45 degree fundus photograph. NIDEK AFC-230 fundus camera. Posterior pole photograph.
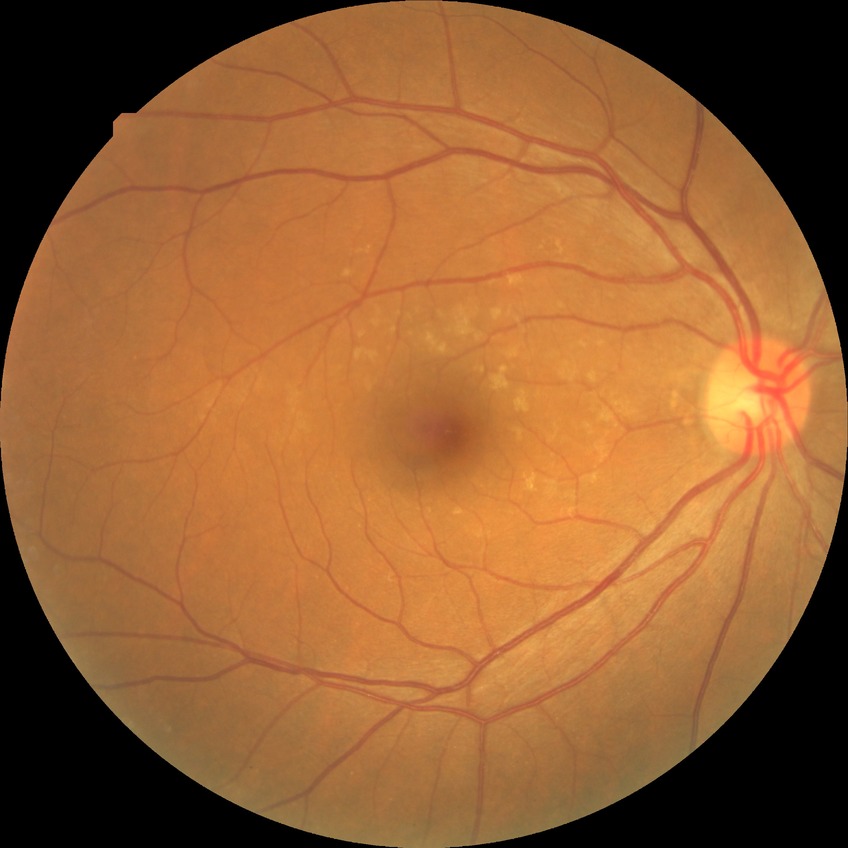
Diabetic retinopathy severity is no diabetic retinopathy.